Color fundus photograph.
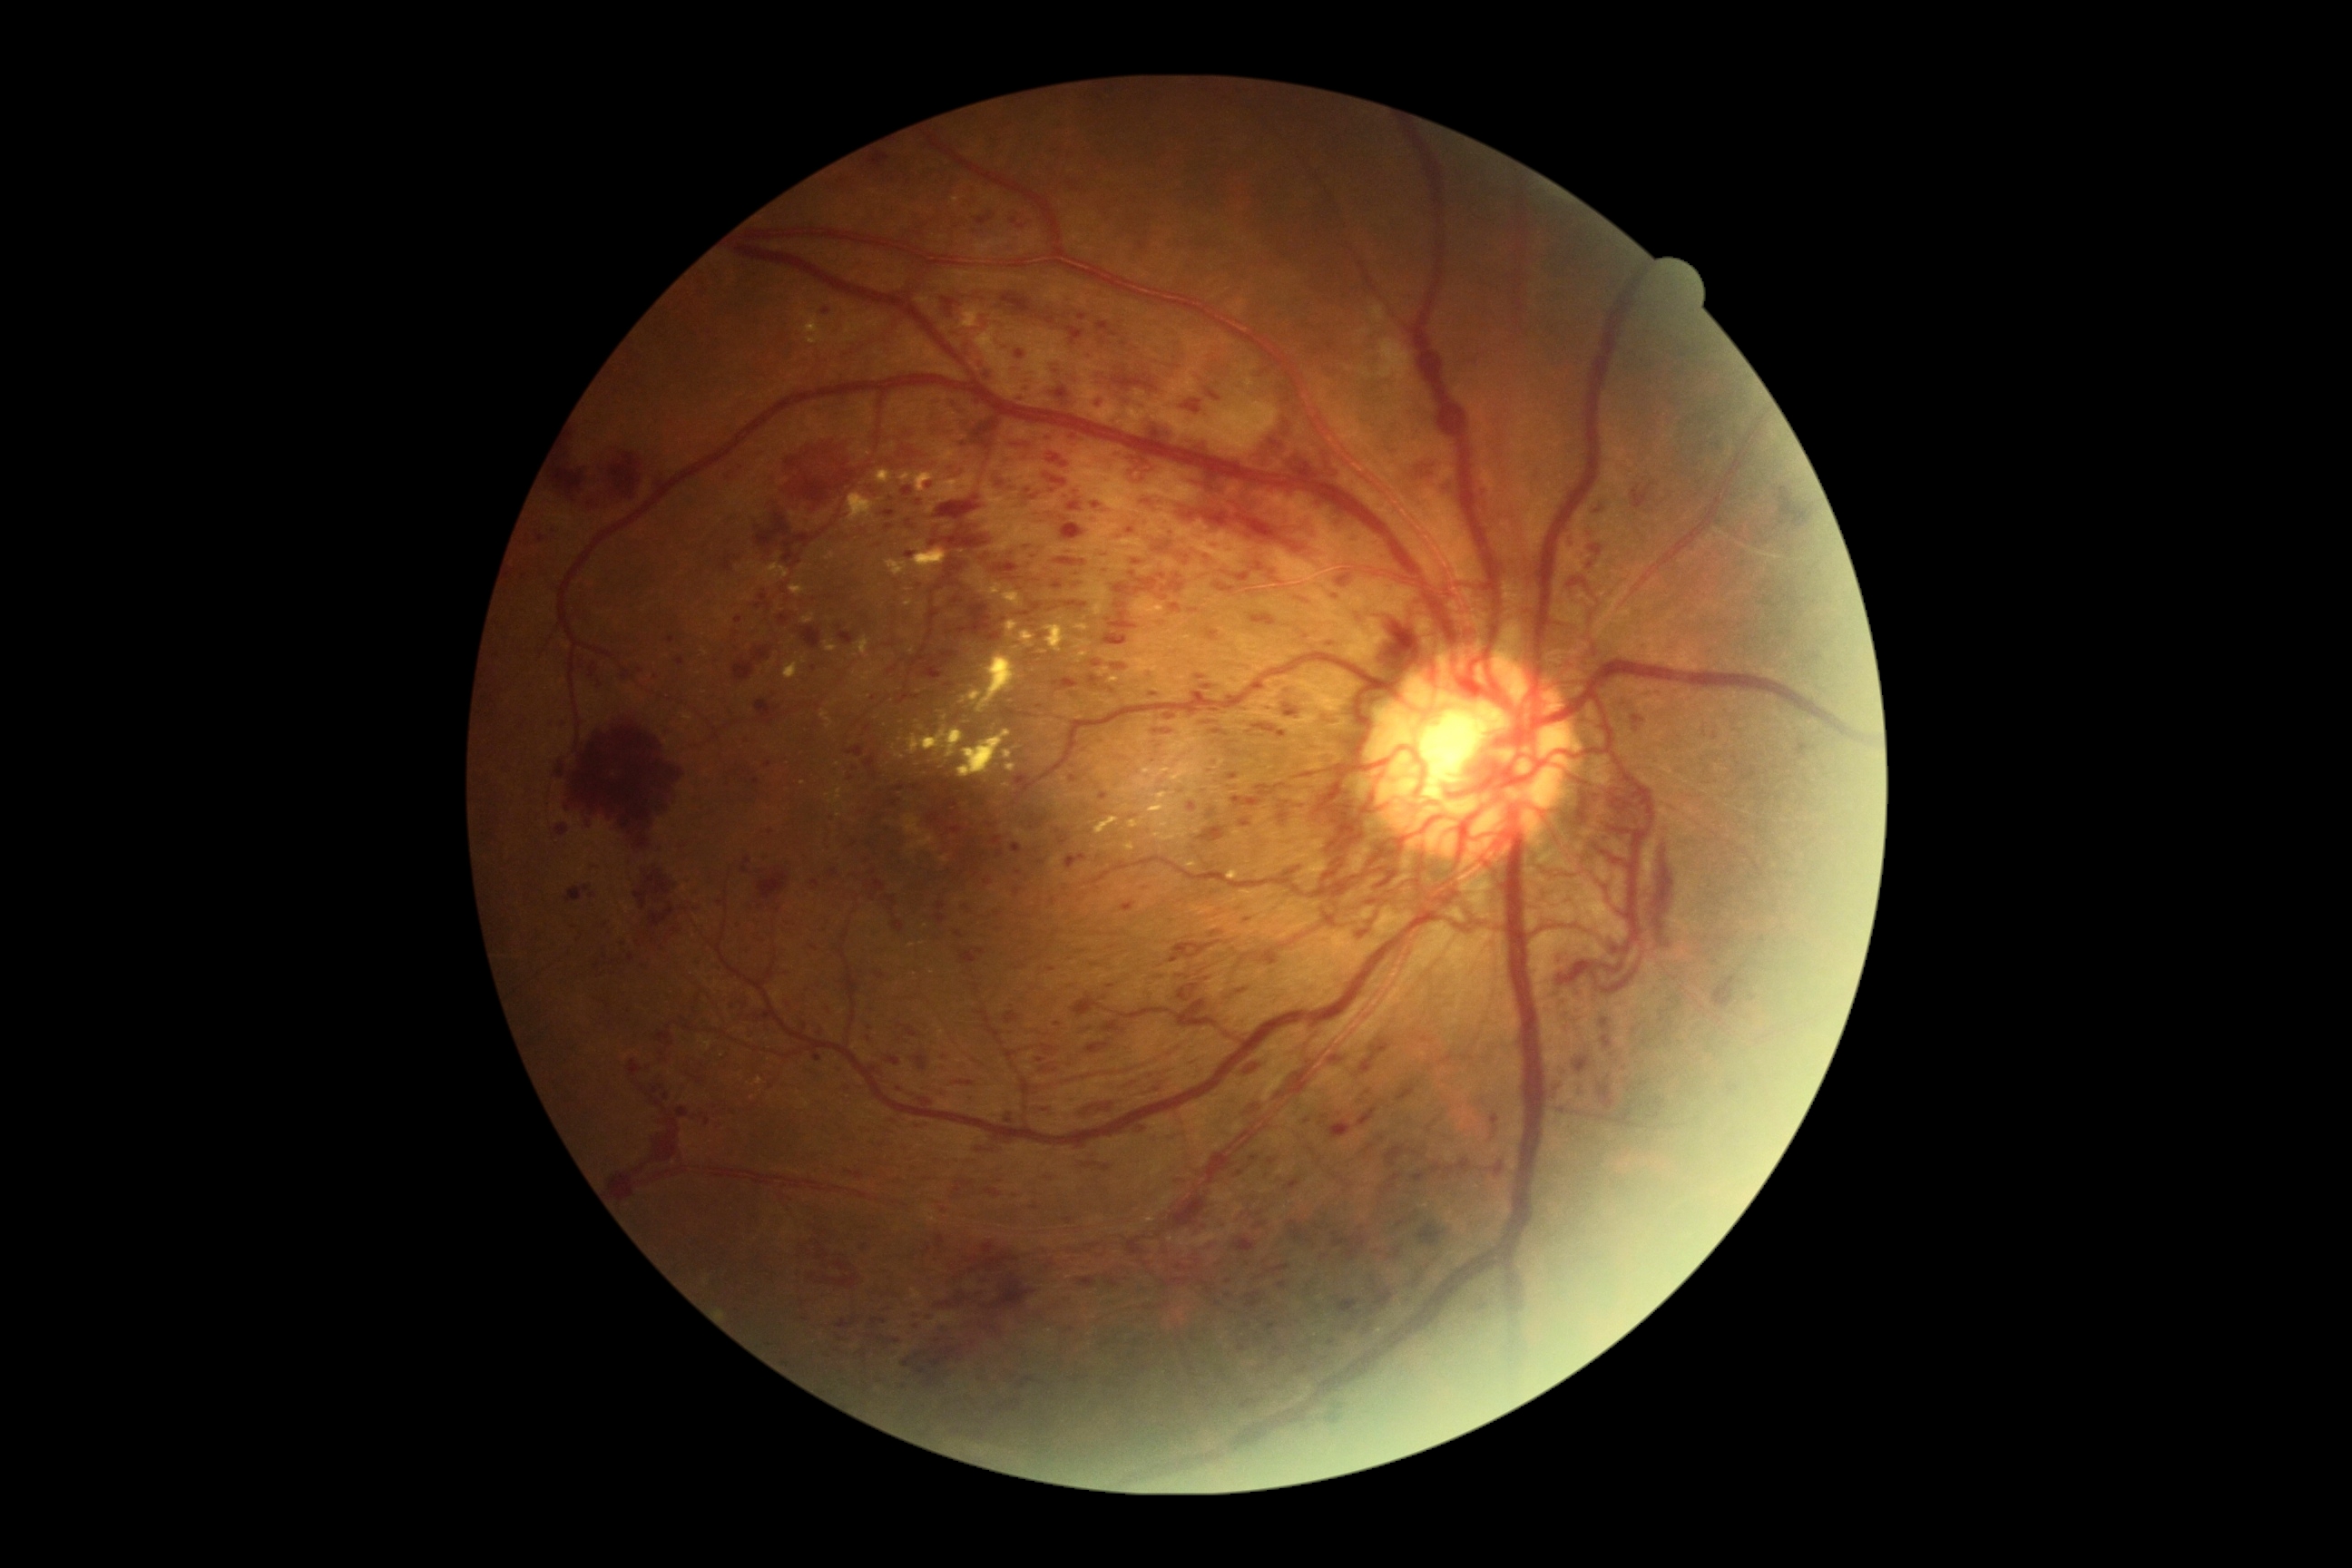 <lesions partial="true">
  <dr_grade>4</dr_grade>
  <ma partial="true">1099/792/1108/801 | 810/946/819/952 | 1137/1126/1153/1137 | 1023/384/1034/393 | 1023/398/1028/406 | 1150/692/1159/698 | 901/487/914/496 | 814/1054/823/1061 | 1126/531/1135/538</ma>
  <ma_small_centers>(723; 970) | (1166; 1253) | (1028; 492) | (931; 486) | (1332; 1343) | (1412; 1303) | (1015; 222) | (1228; 1282)</ma_small_centers>
  <he partial="true">994/564/1019/574 | 930/524/990/549 | 1037/1259/1057/1275 | 1102/574/1159/656 | 1081/1102/1113/1117 | 1079/315/1088/322 | 1010/578/1019/582 | 1088/676/1102/689 | 1647/1099/1665/1121 | 892/921/905/934 | 1124/449/1155/482 | 798/625/823/651 | 977/1148/995/1153 | 556/763/565/778 | 1017/1377/1035/1389 | 1046/317/1055/326</he>
  <he_small_centers>(1599; 510) | (979; 1295) | (973; 1345)</he_small_centers>
</lesions>